Wide-field contact fundus photograph of an infant · Phoenix ICON, 100° FOV.
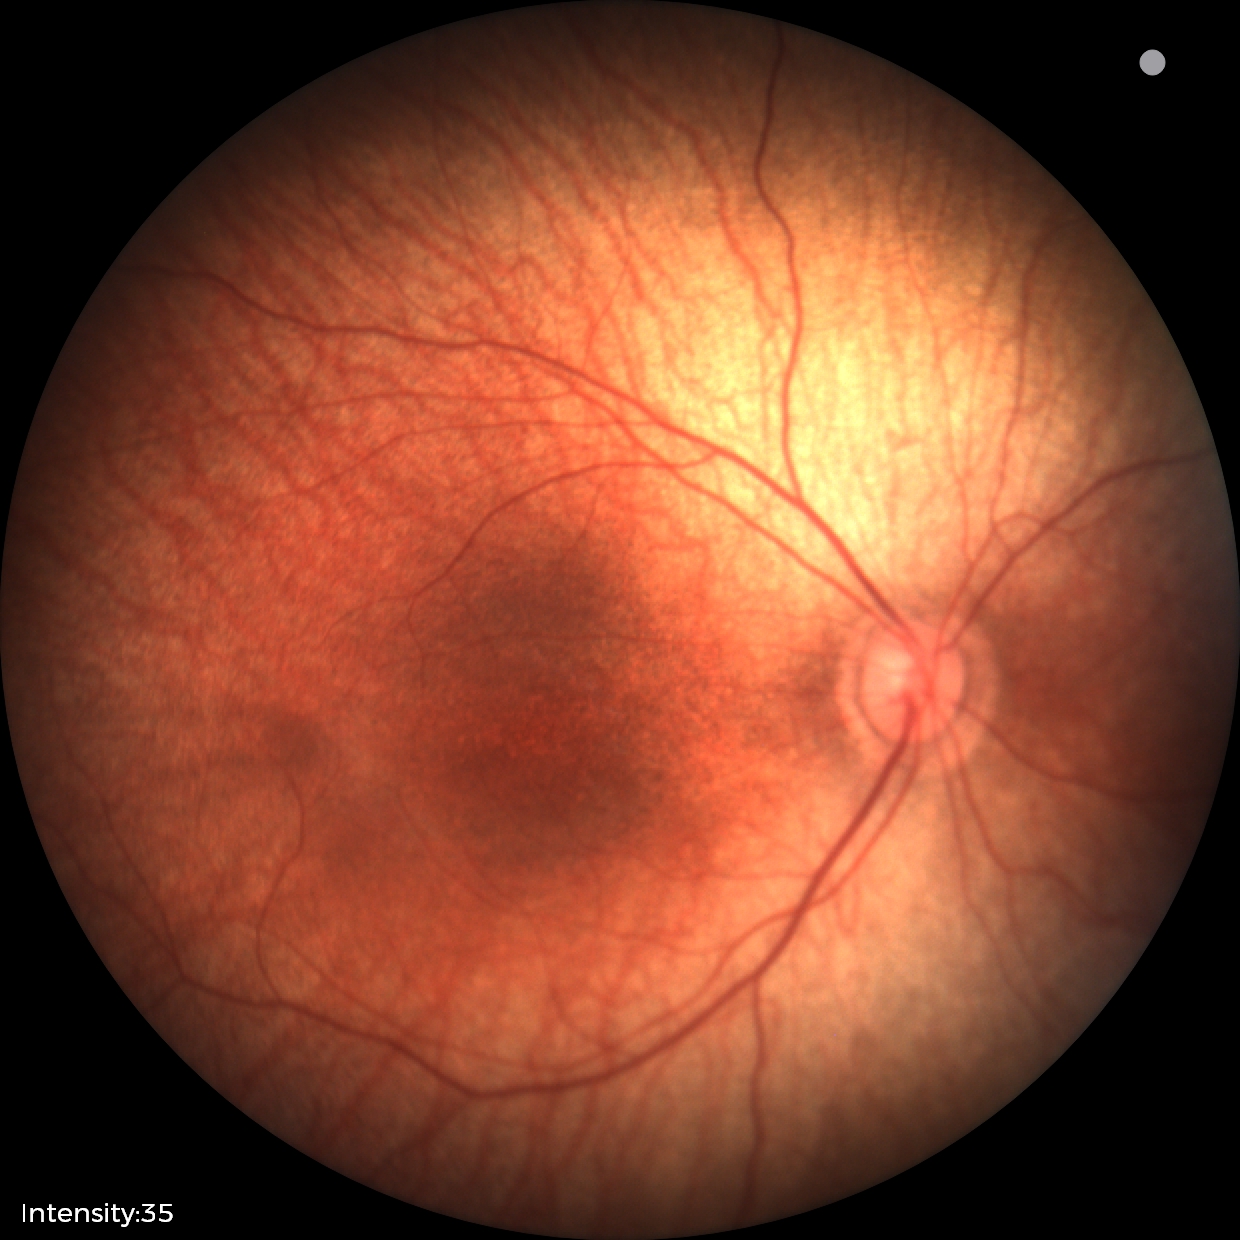
Assessment: normal retinal appearance.